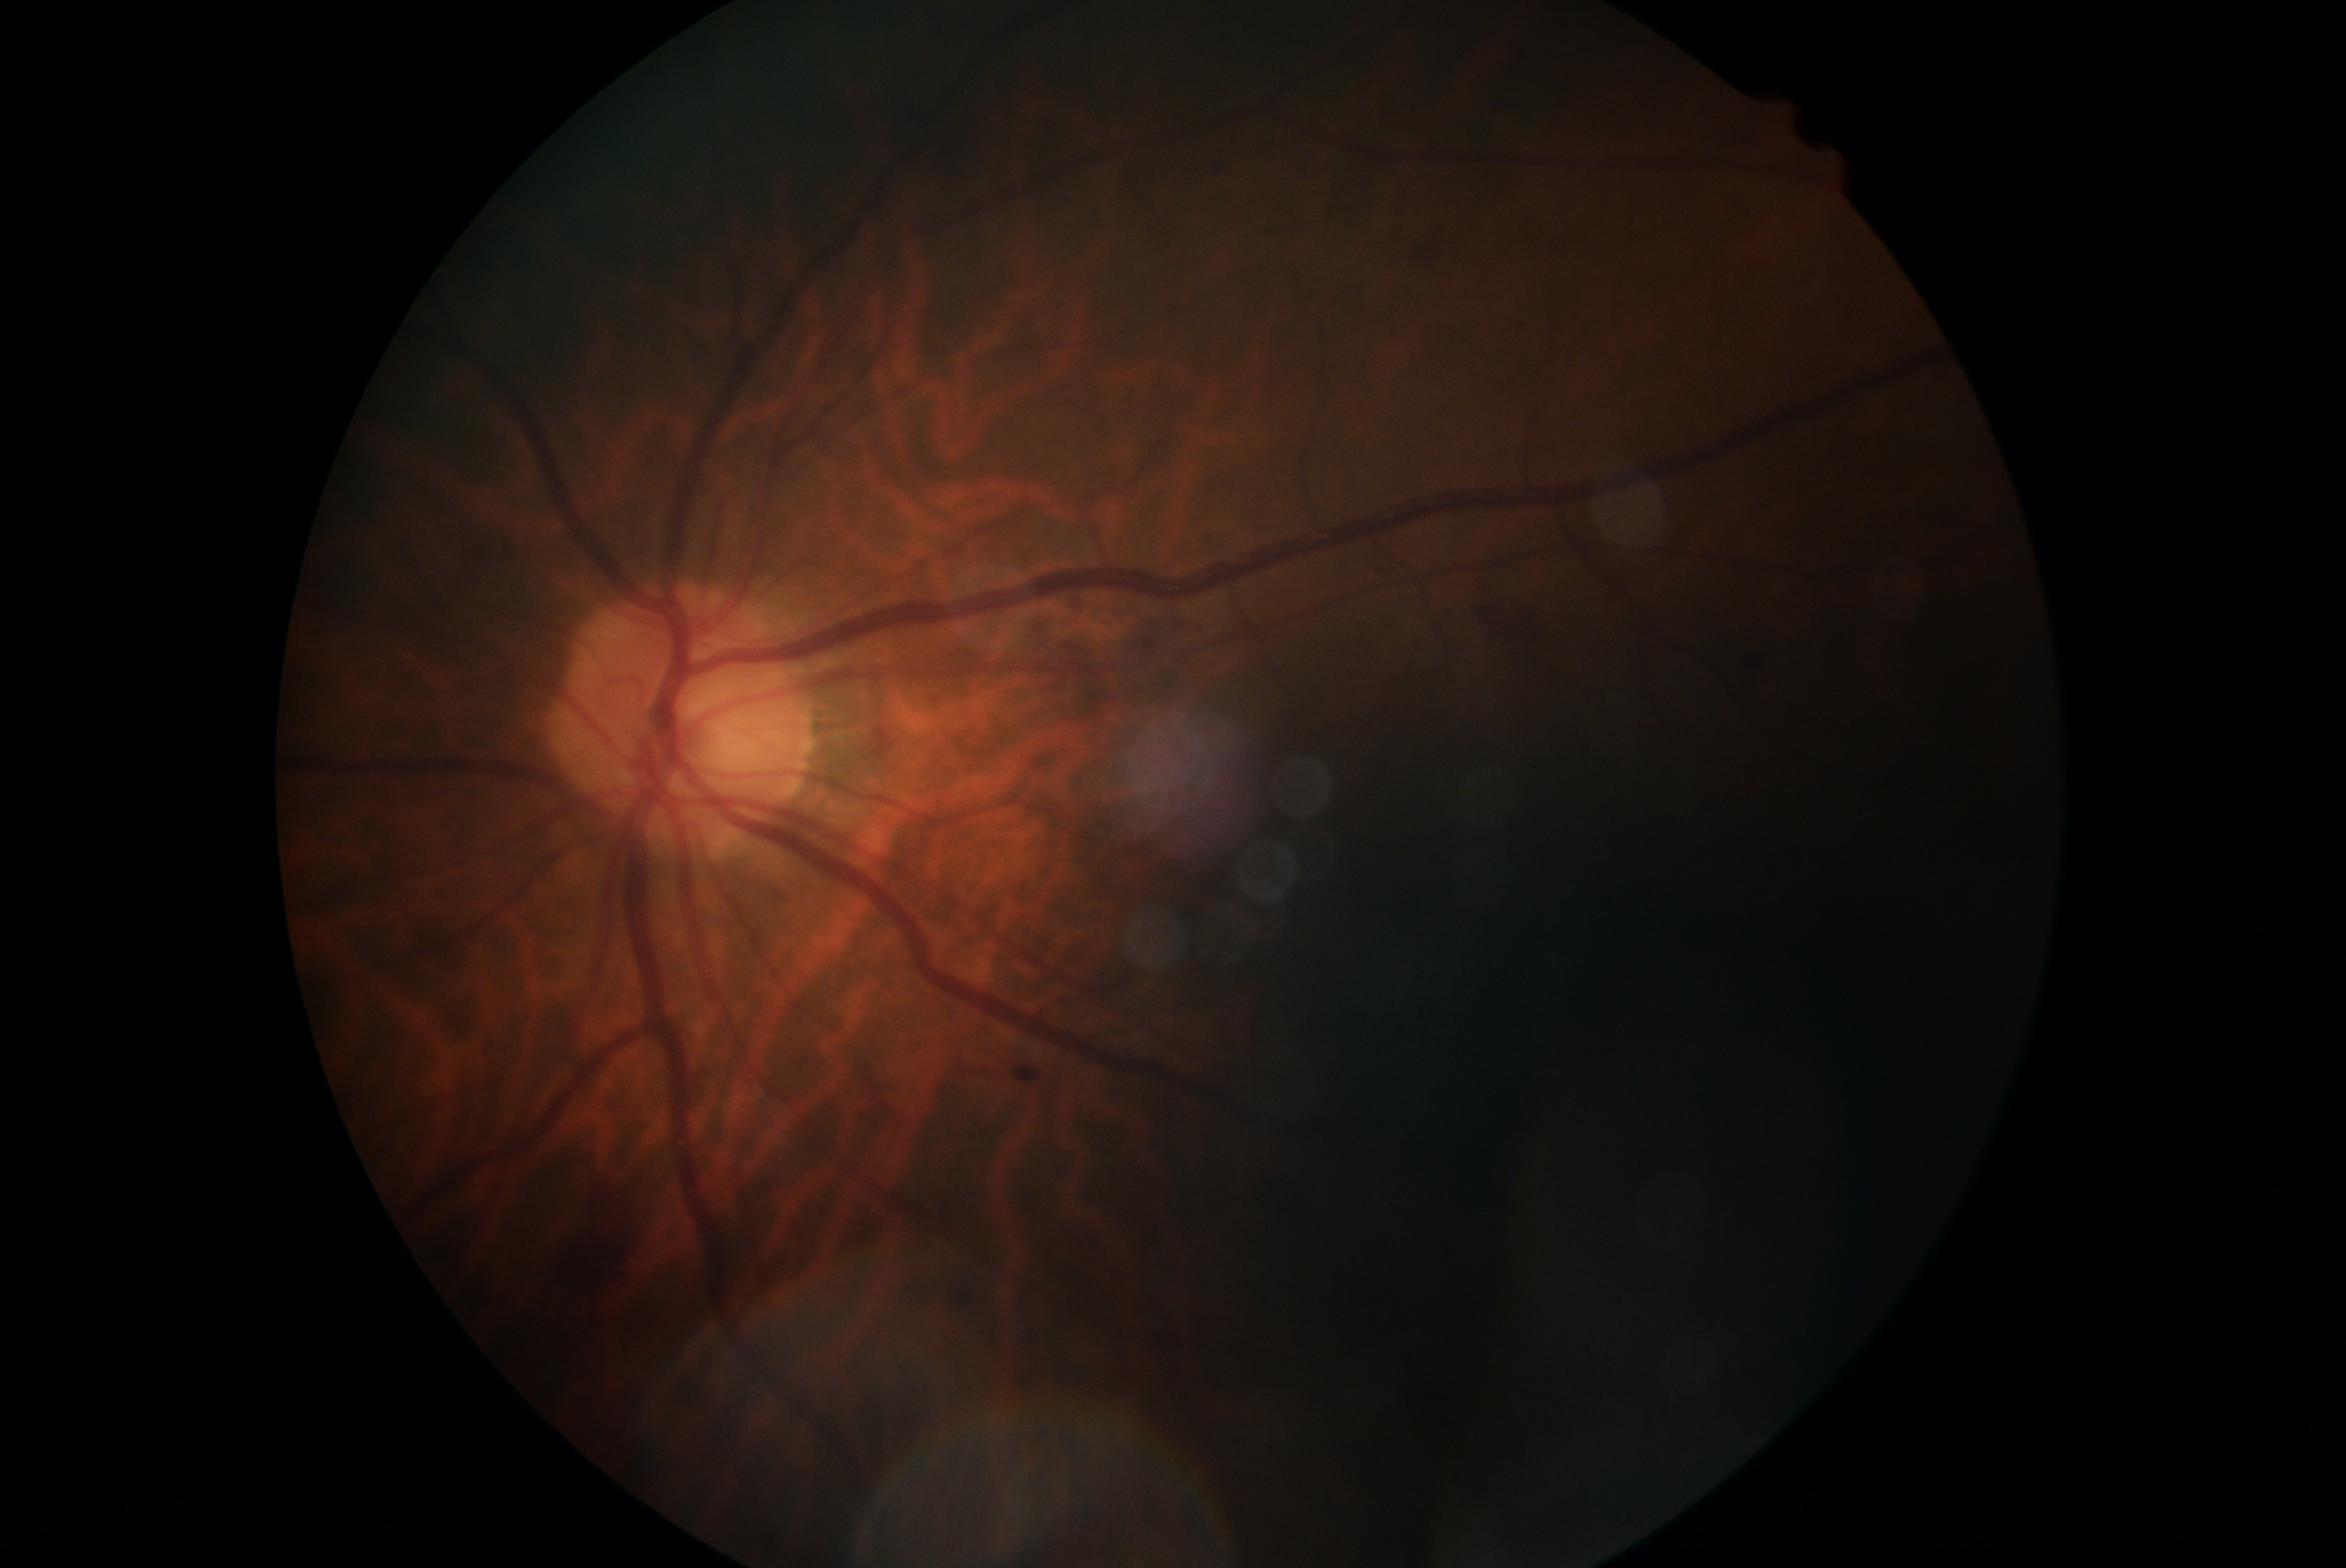

Diabetic retinopathy (DR): grade 2.
The retinopathy is classified as non-proliferative diabetic retinopathy.